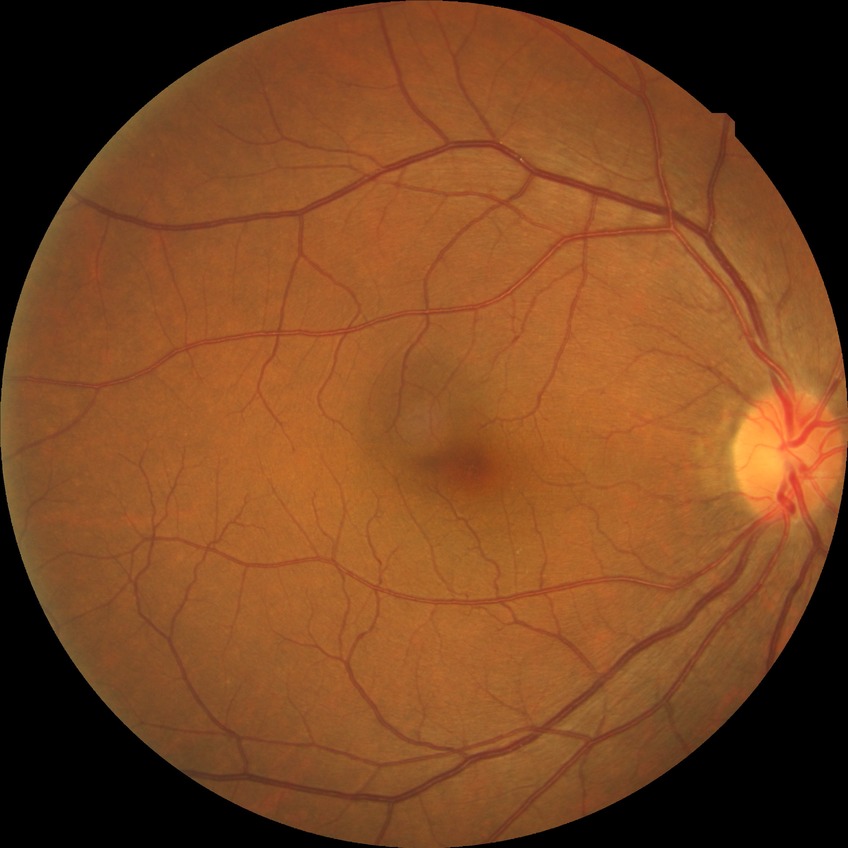   davis_grade: NDR
  dr_impression: negative for DR